CFP
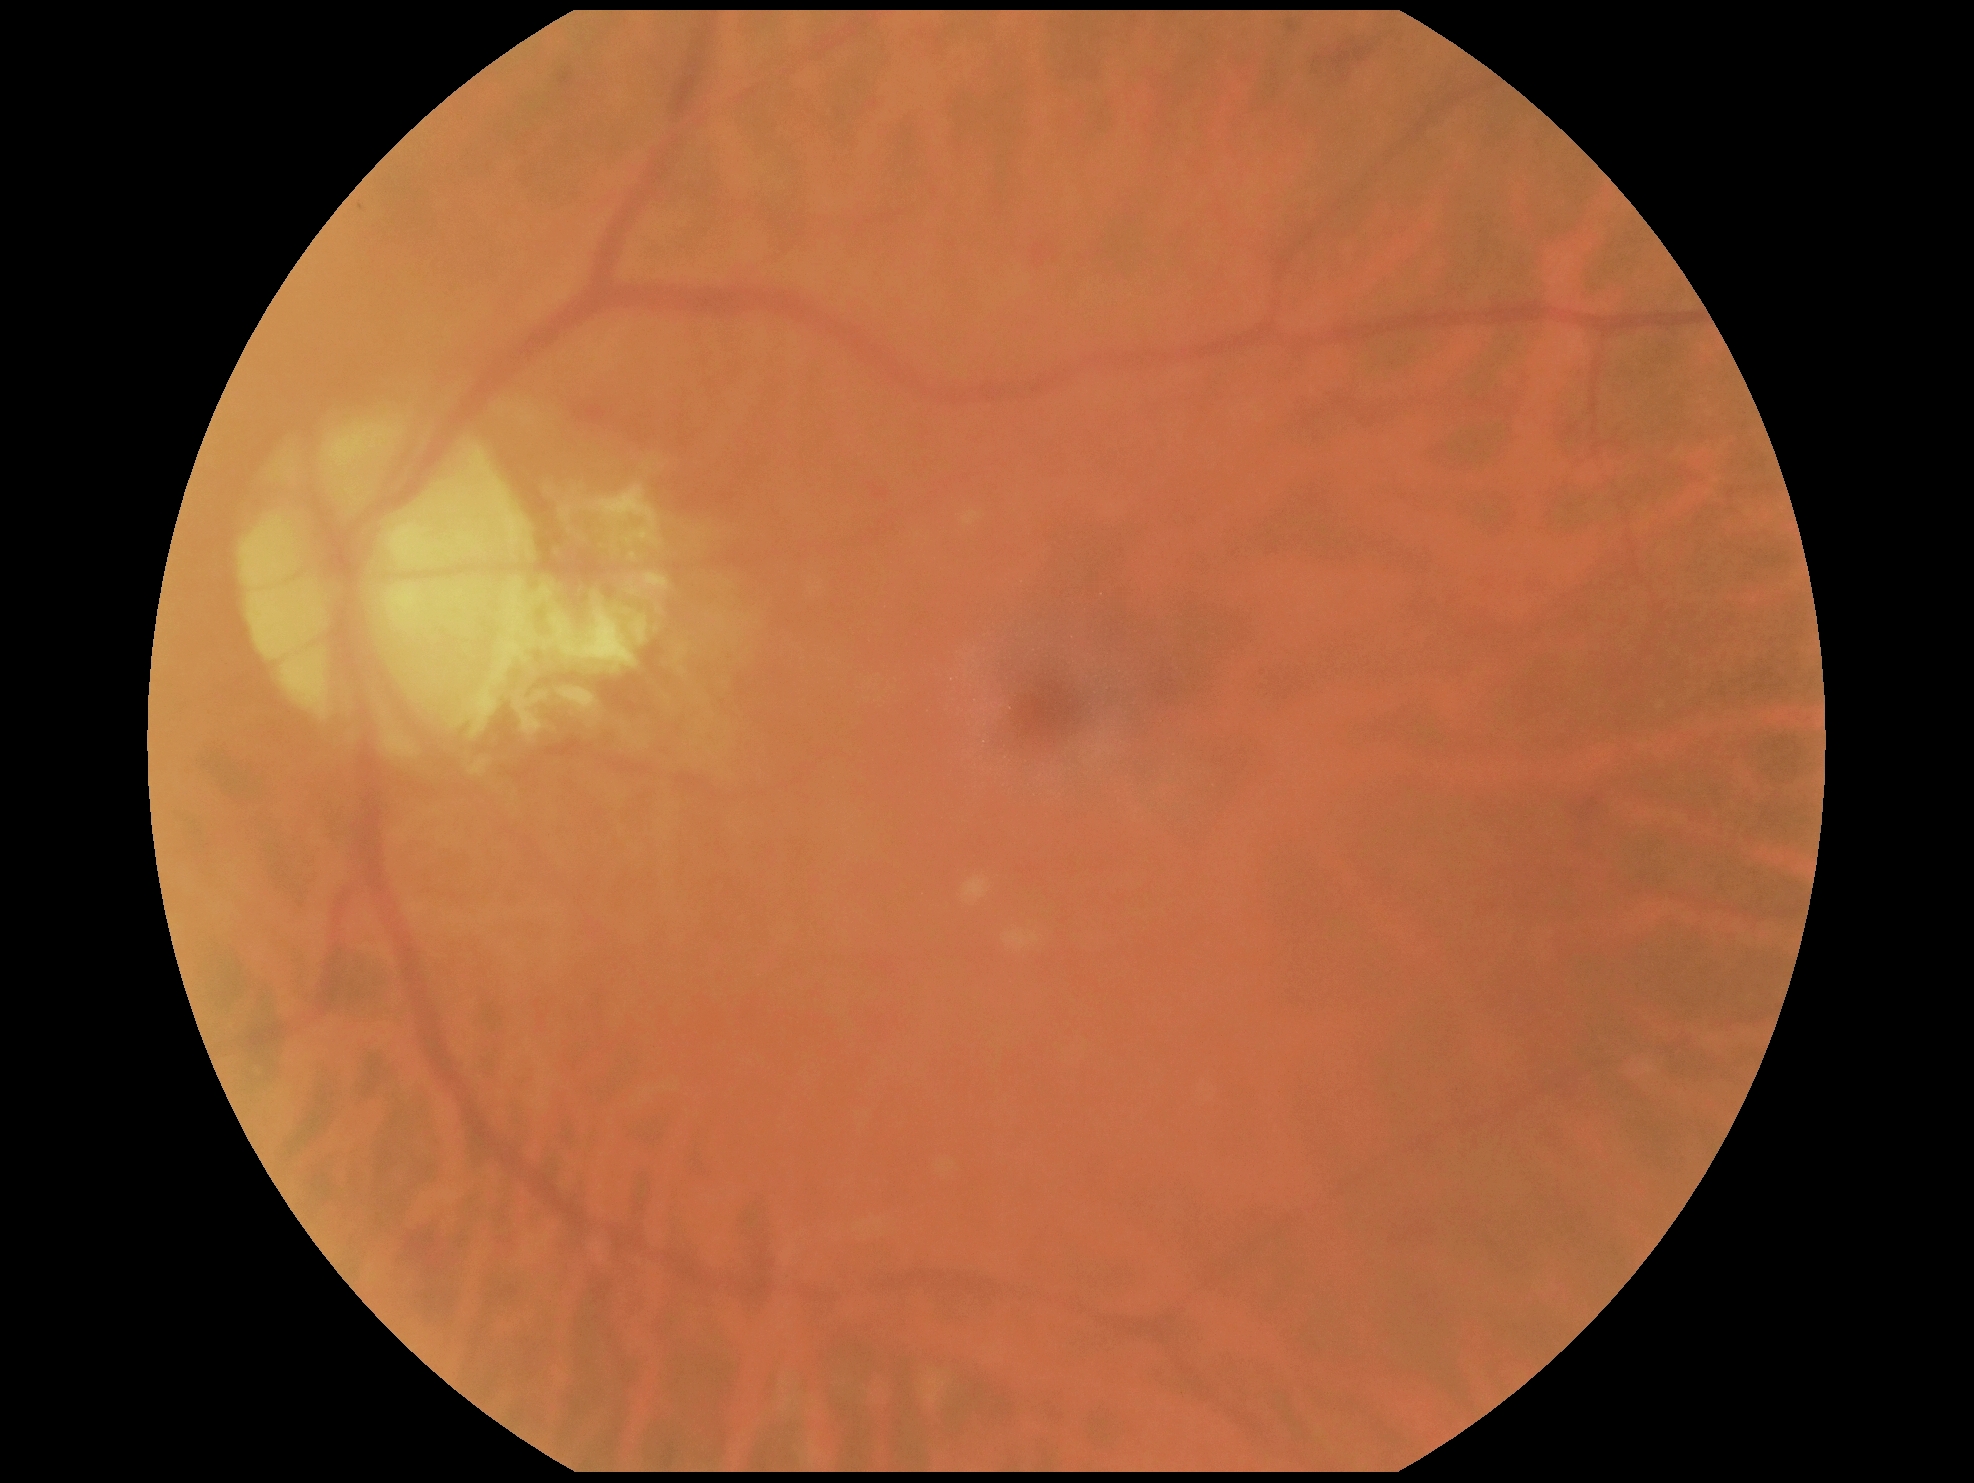

Diabetic retinopathy (DR): grade 2 (moderate NPDR) — more than just microaneurysms but less than severe NPDR.